FOV: 45 degrees, image size 848x848
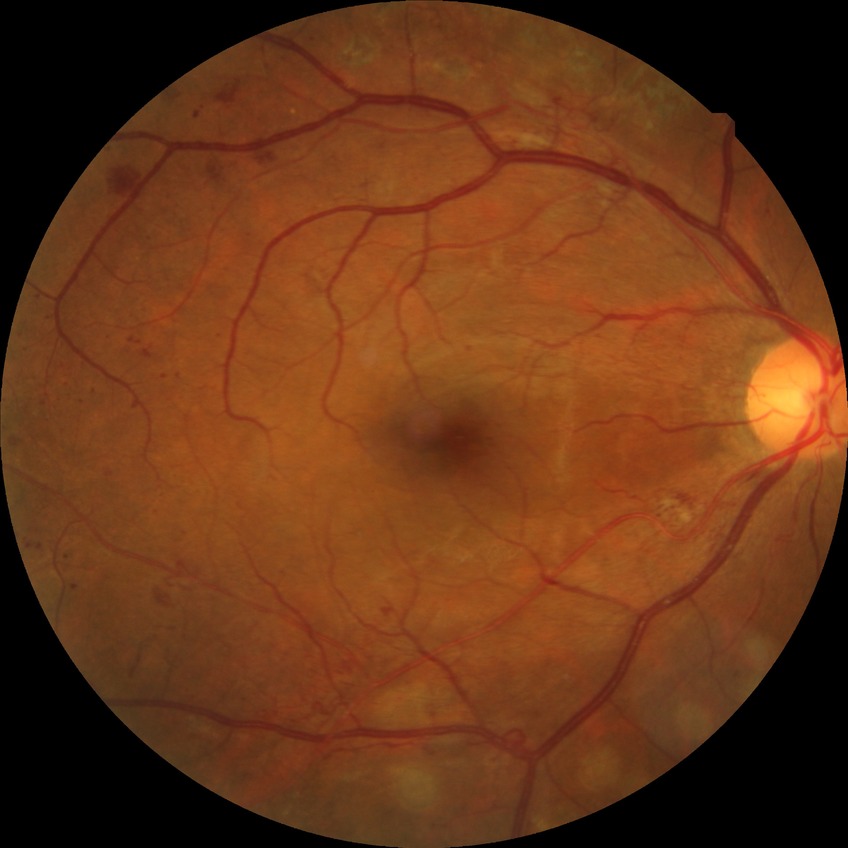 Diabetic retinopathy severity: proliferative diabetic retinopathy.